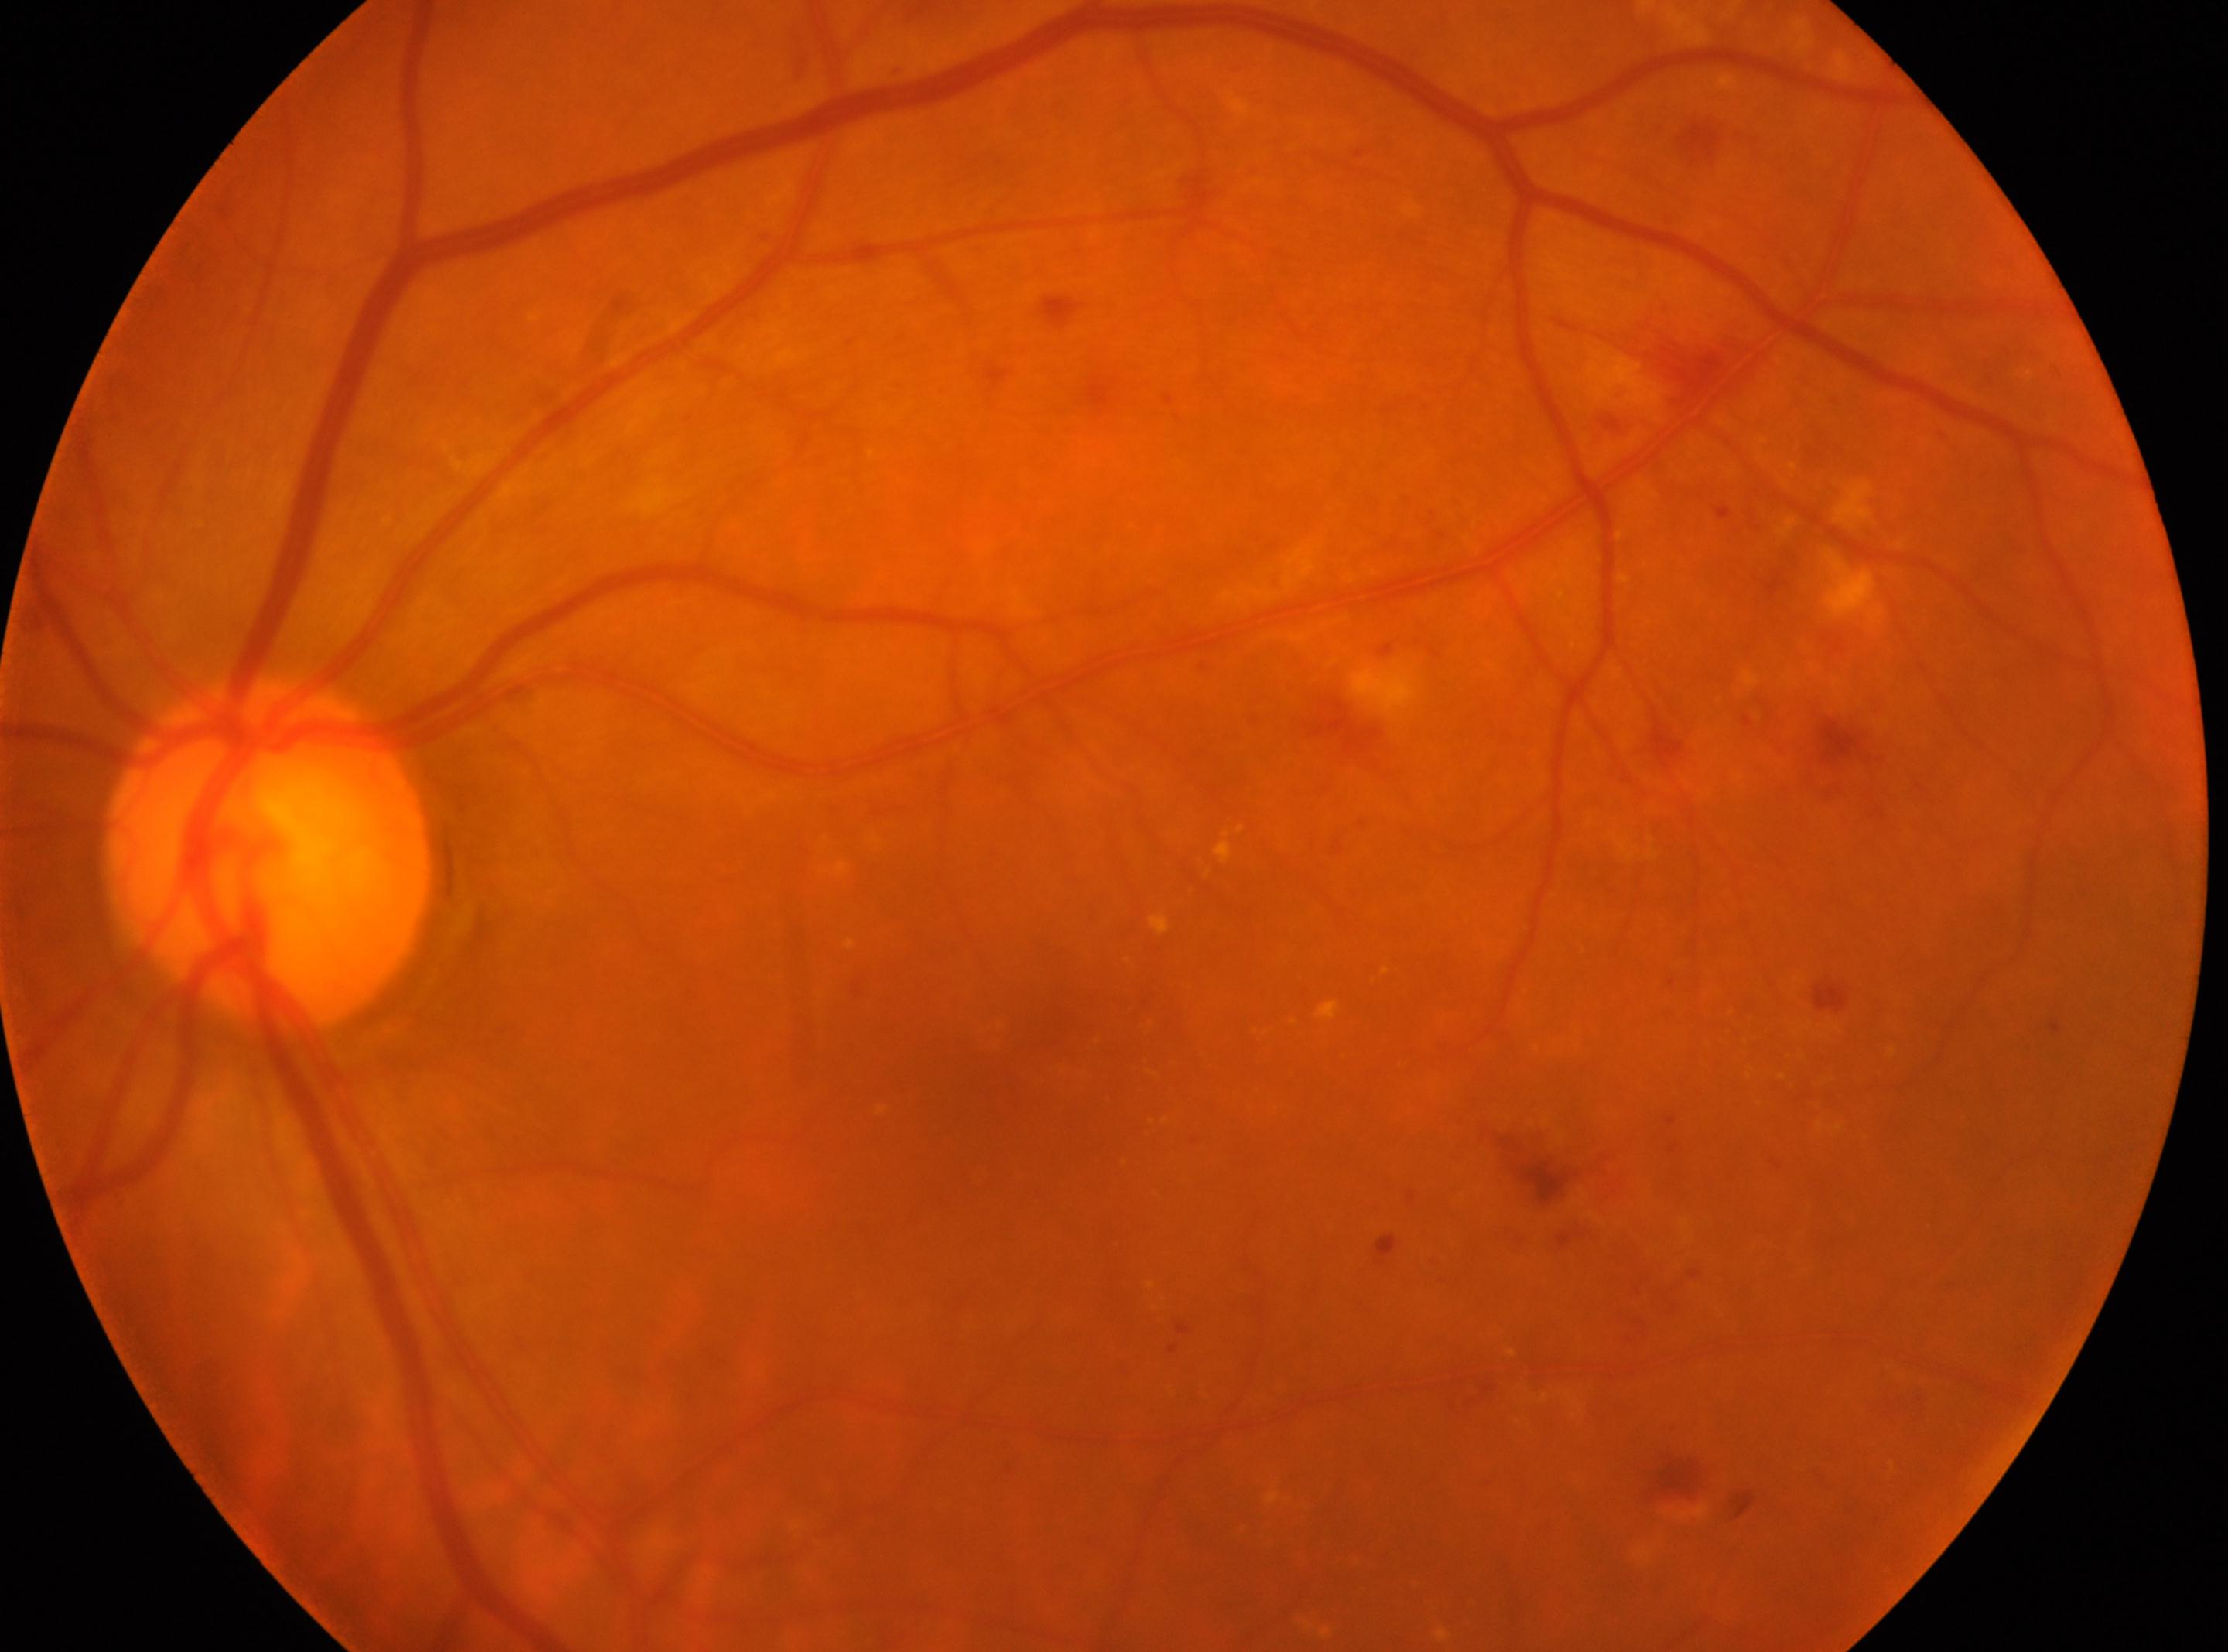 The macula center is at 996px, 1091px. Eye: the left eye. ONH: 268px, 855px. Diabetic retinopathy (DR) is 2/4.